Infant wide-field fundus photograph — 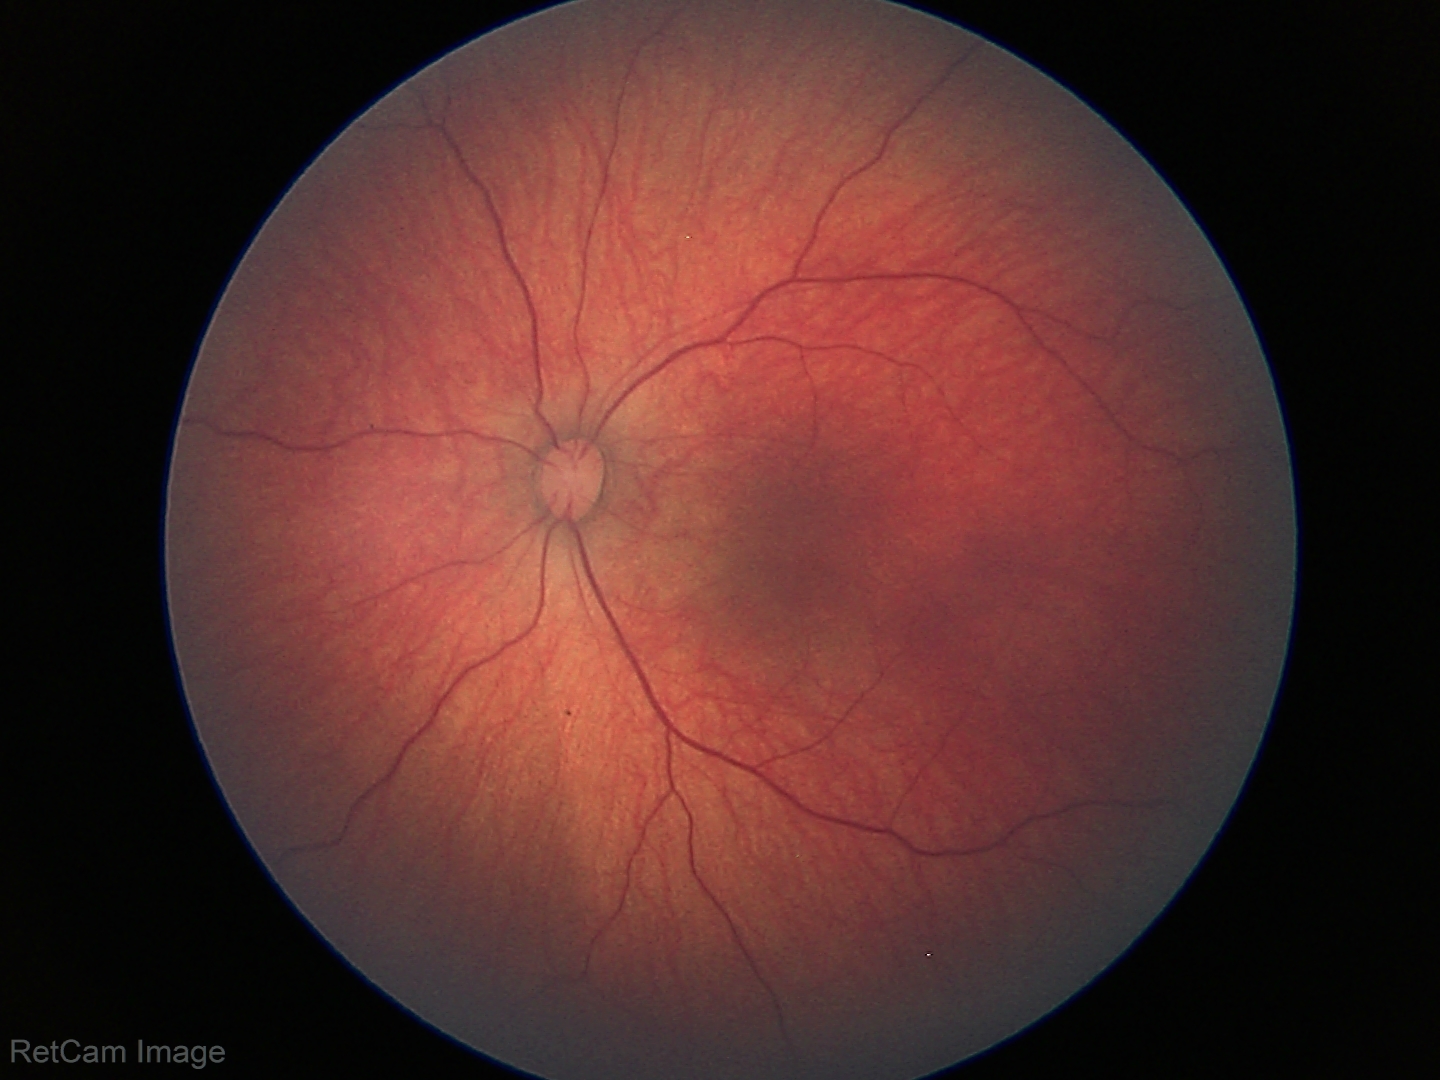
Screening examination consistent with retinal hemorrhages.